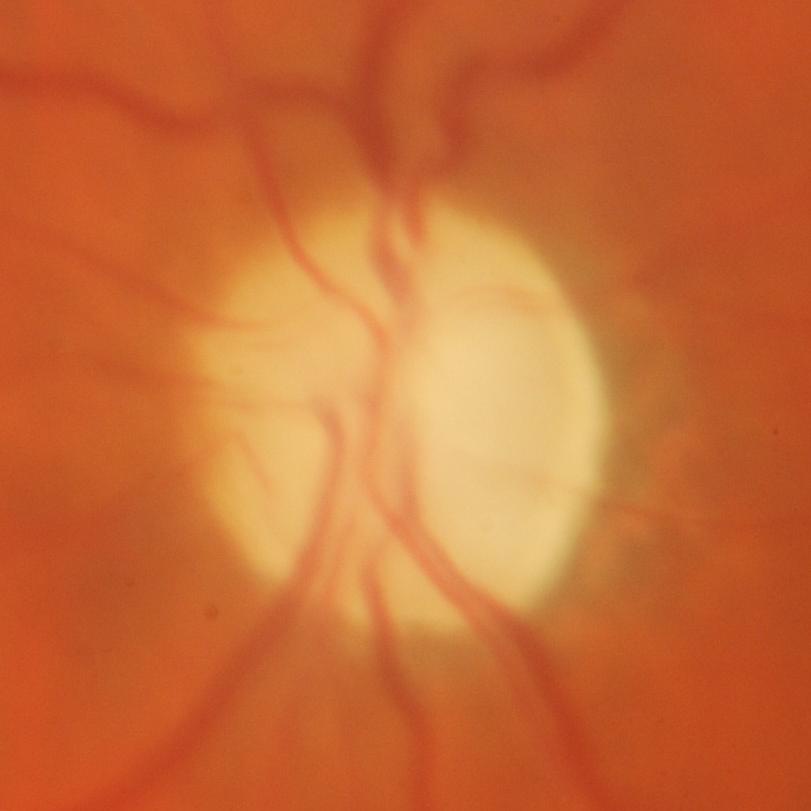

Glaucoma is present.
Glaucomatous damage to the optic nerve.